Wide-field fundus photograph of an infant; 1240 by 1240 pixels; acquired on the Phoenix ICON:
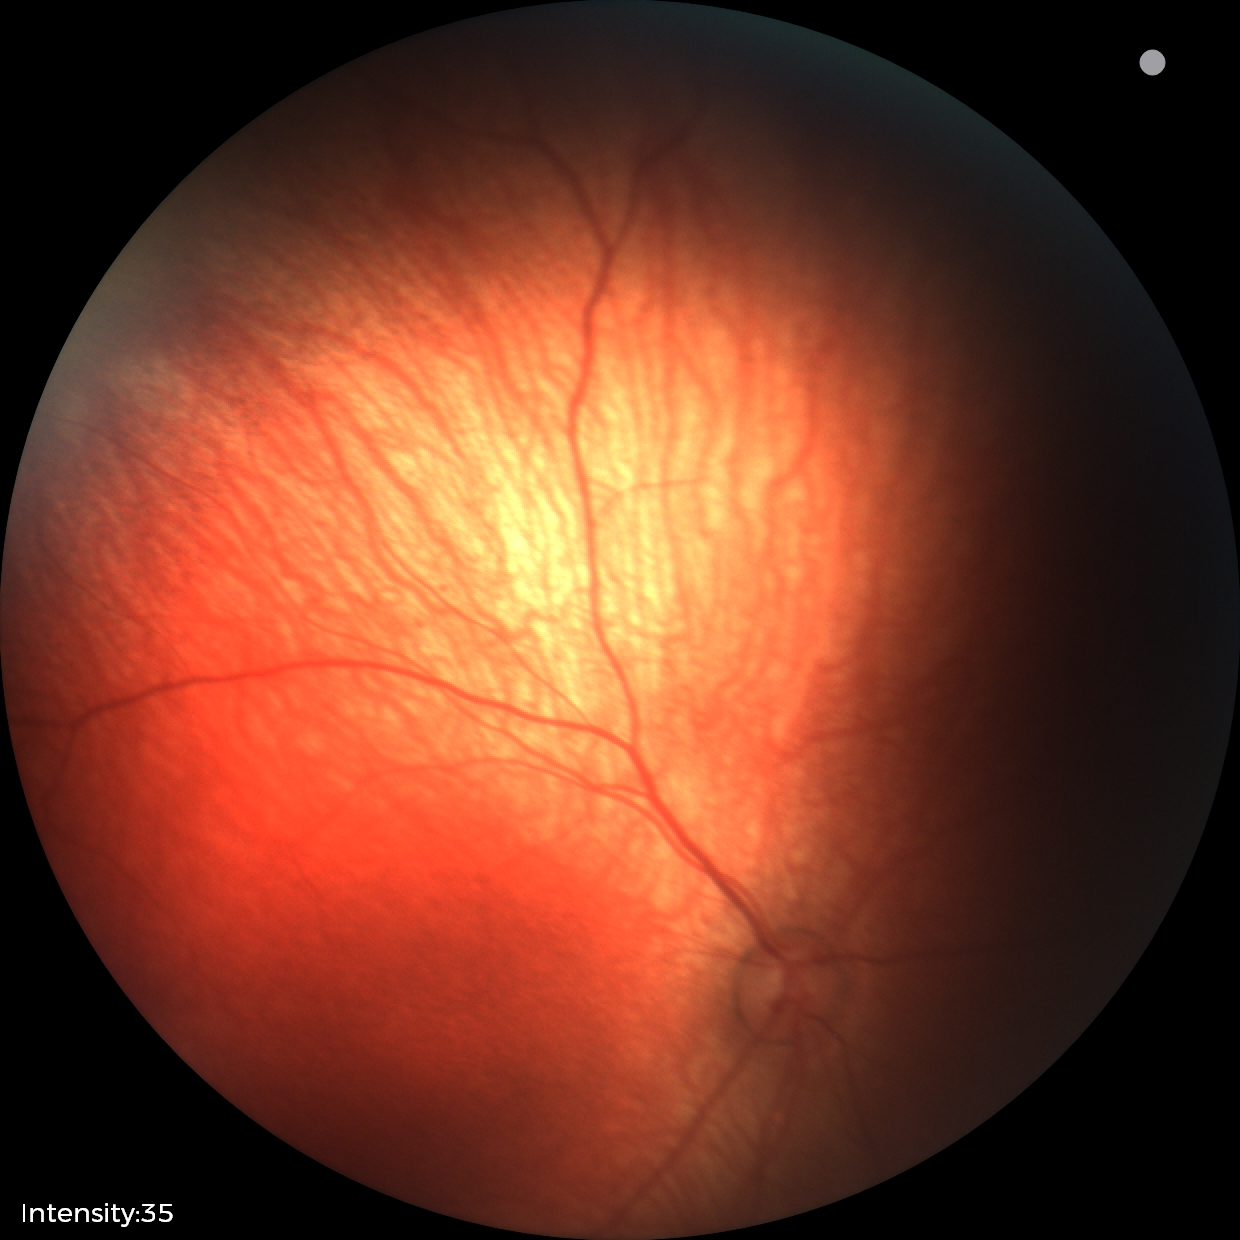 Normal screening examination.